Pediatric wide-field fundus photograph.
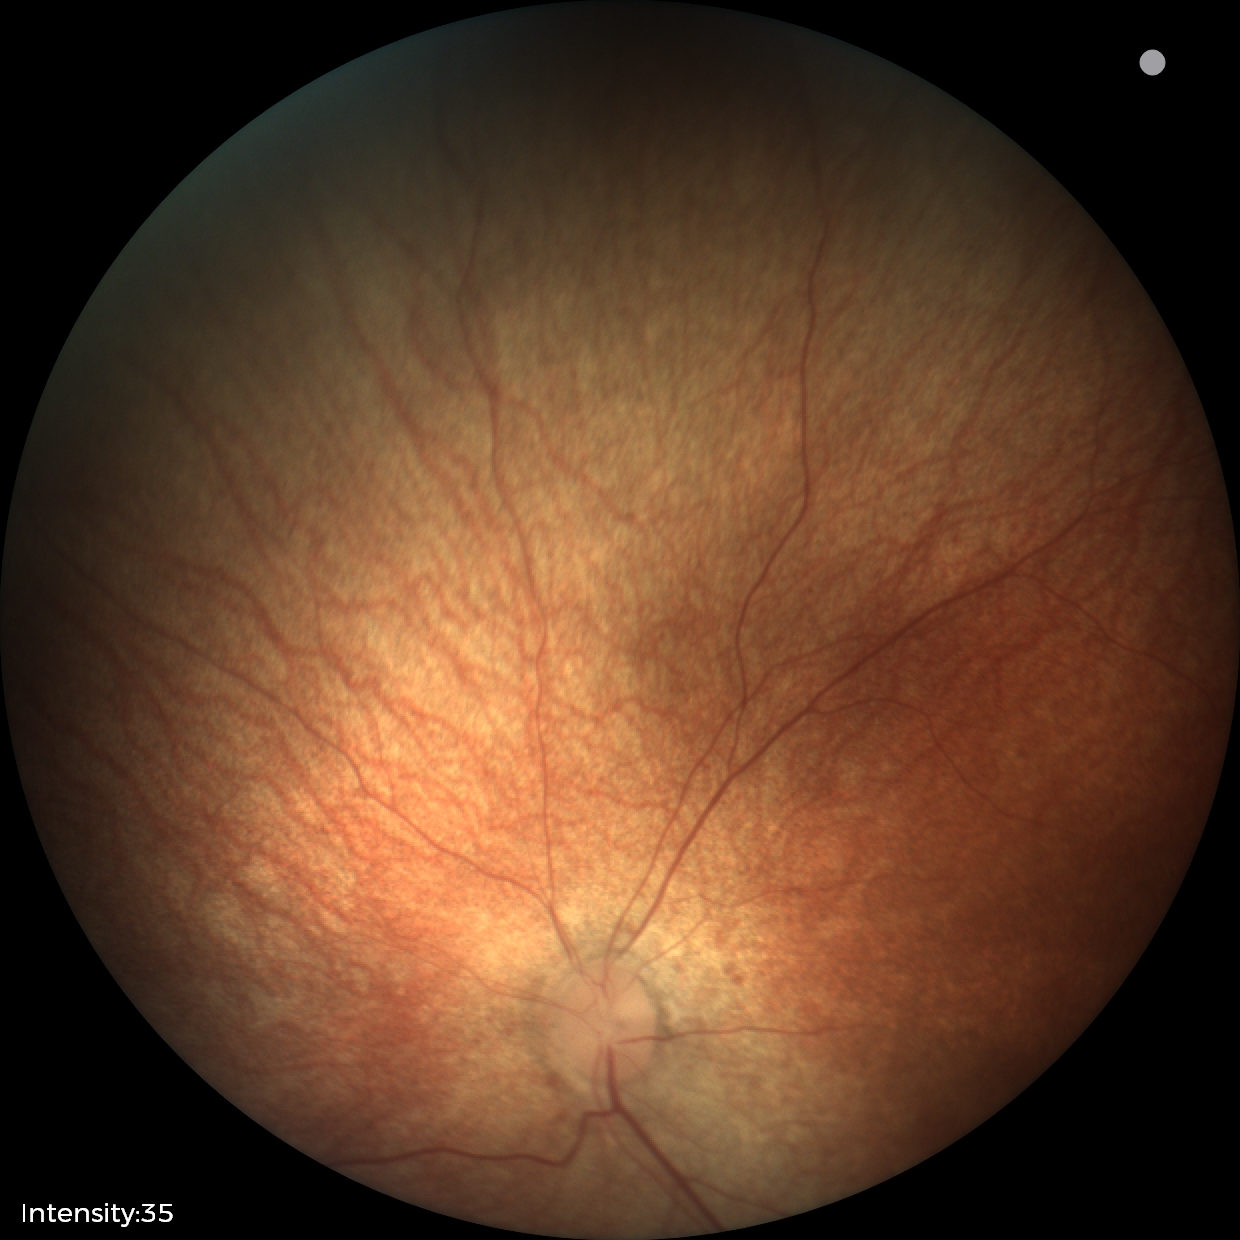
Screening examination with no abnormal retinal findings.